2352 by 1568 pixels · fundus photo · 45° FOV
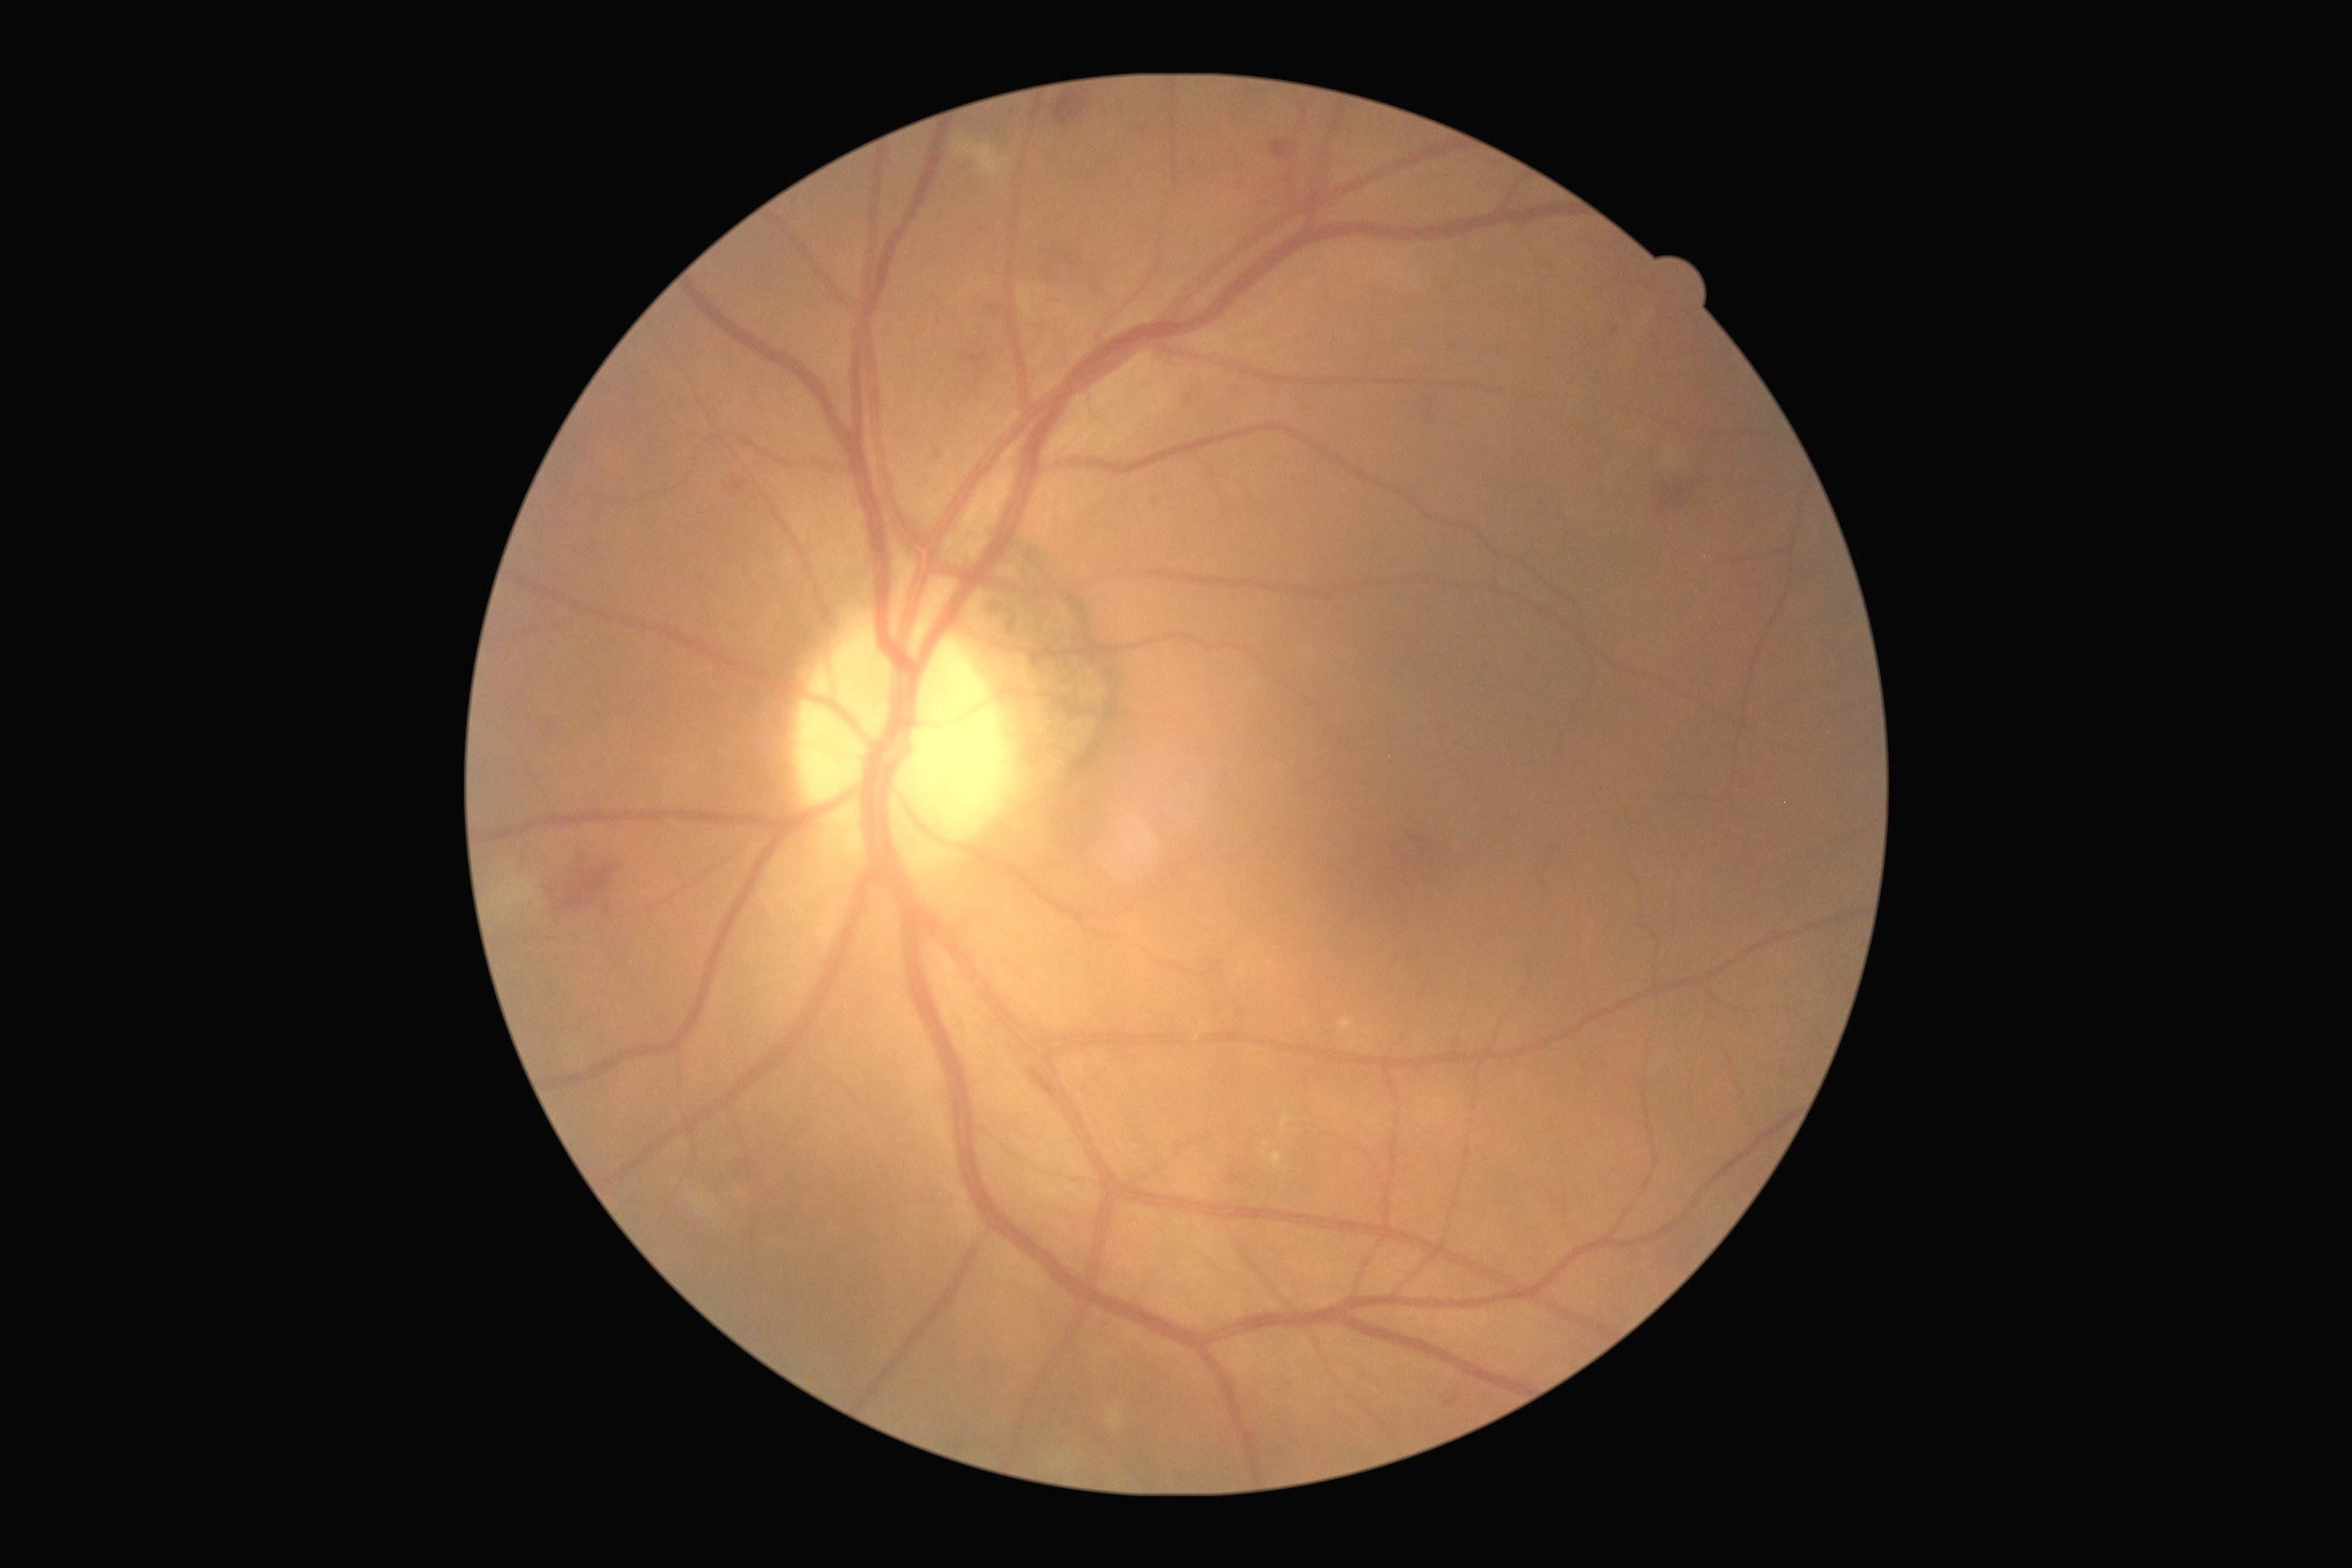

- diabetic retinopathy grade: moderate non-proliferative diabetic retinopathy (2) — more than just microaneurysms but less than severe NPDR